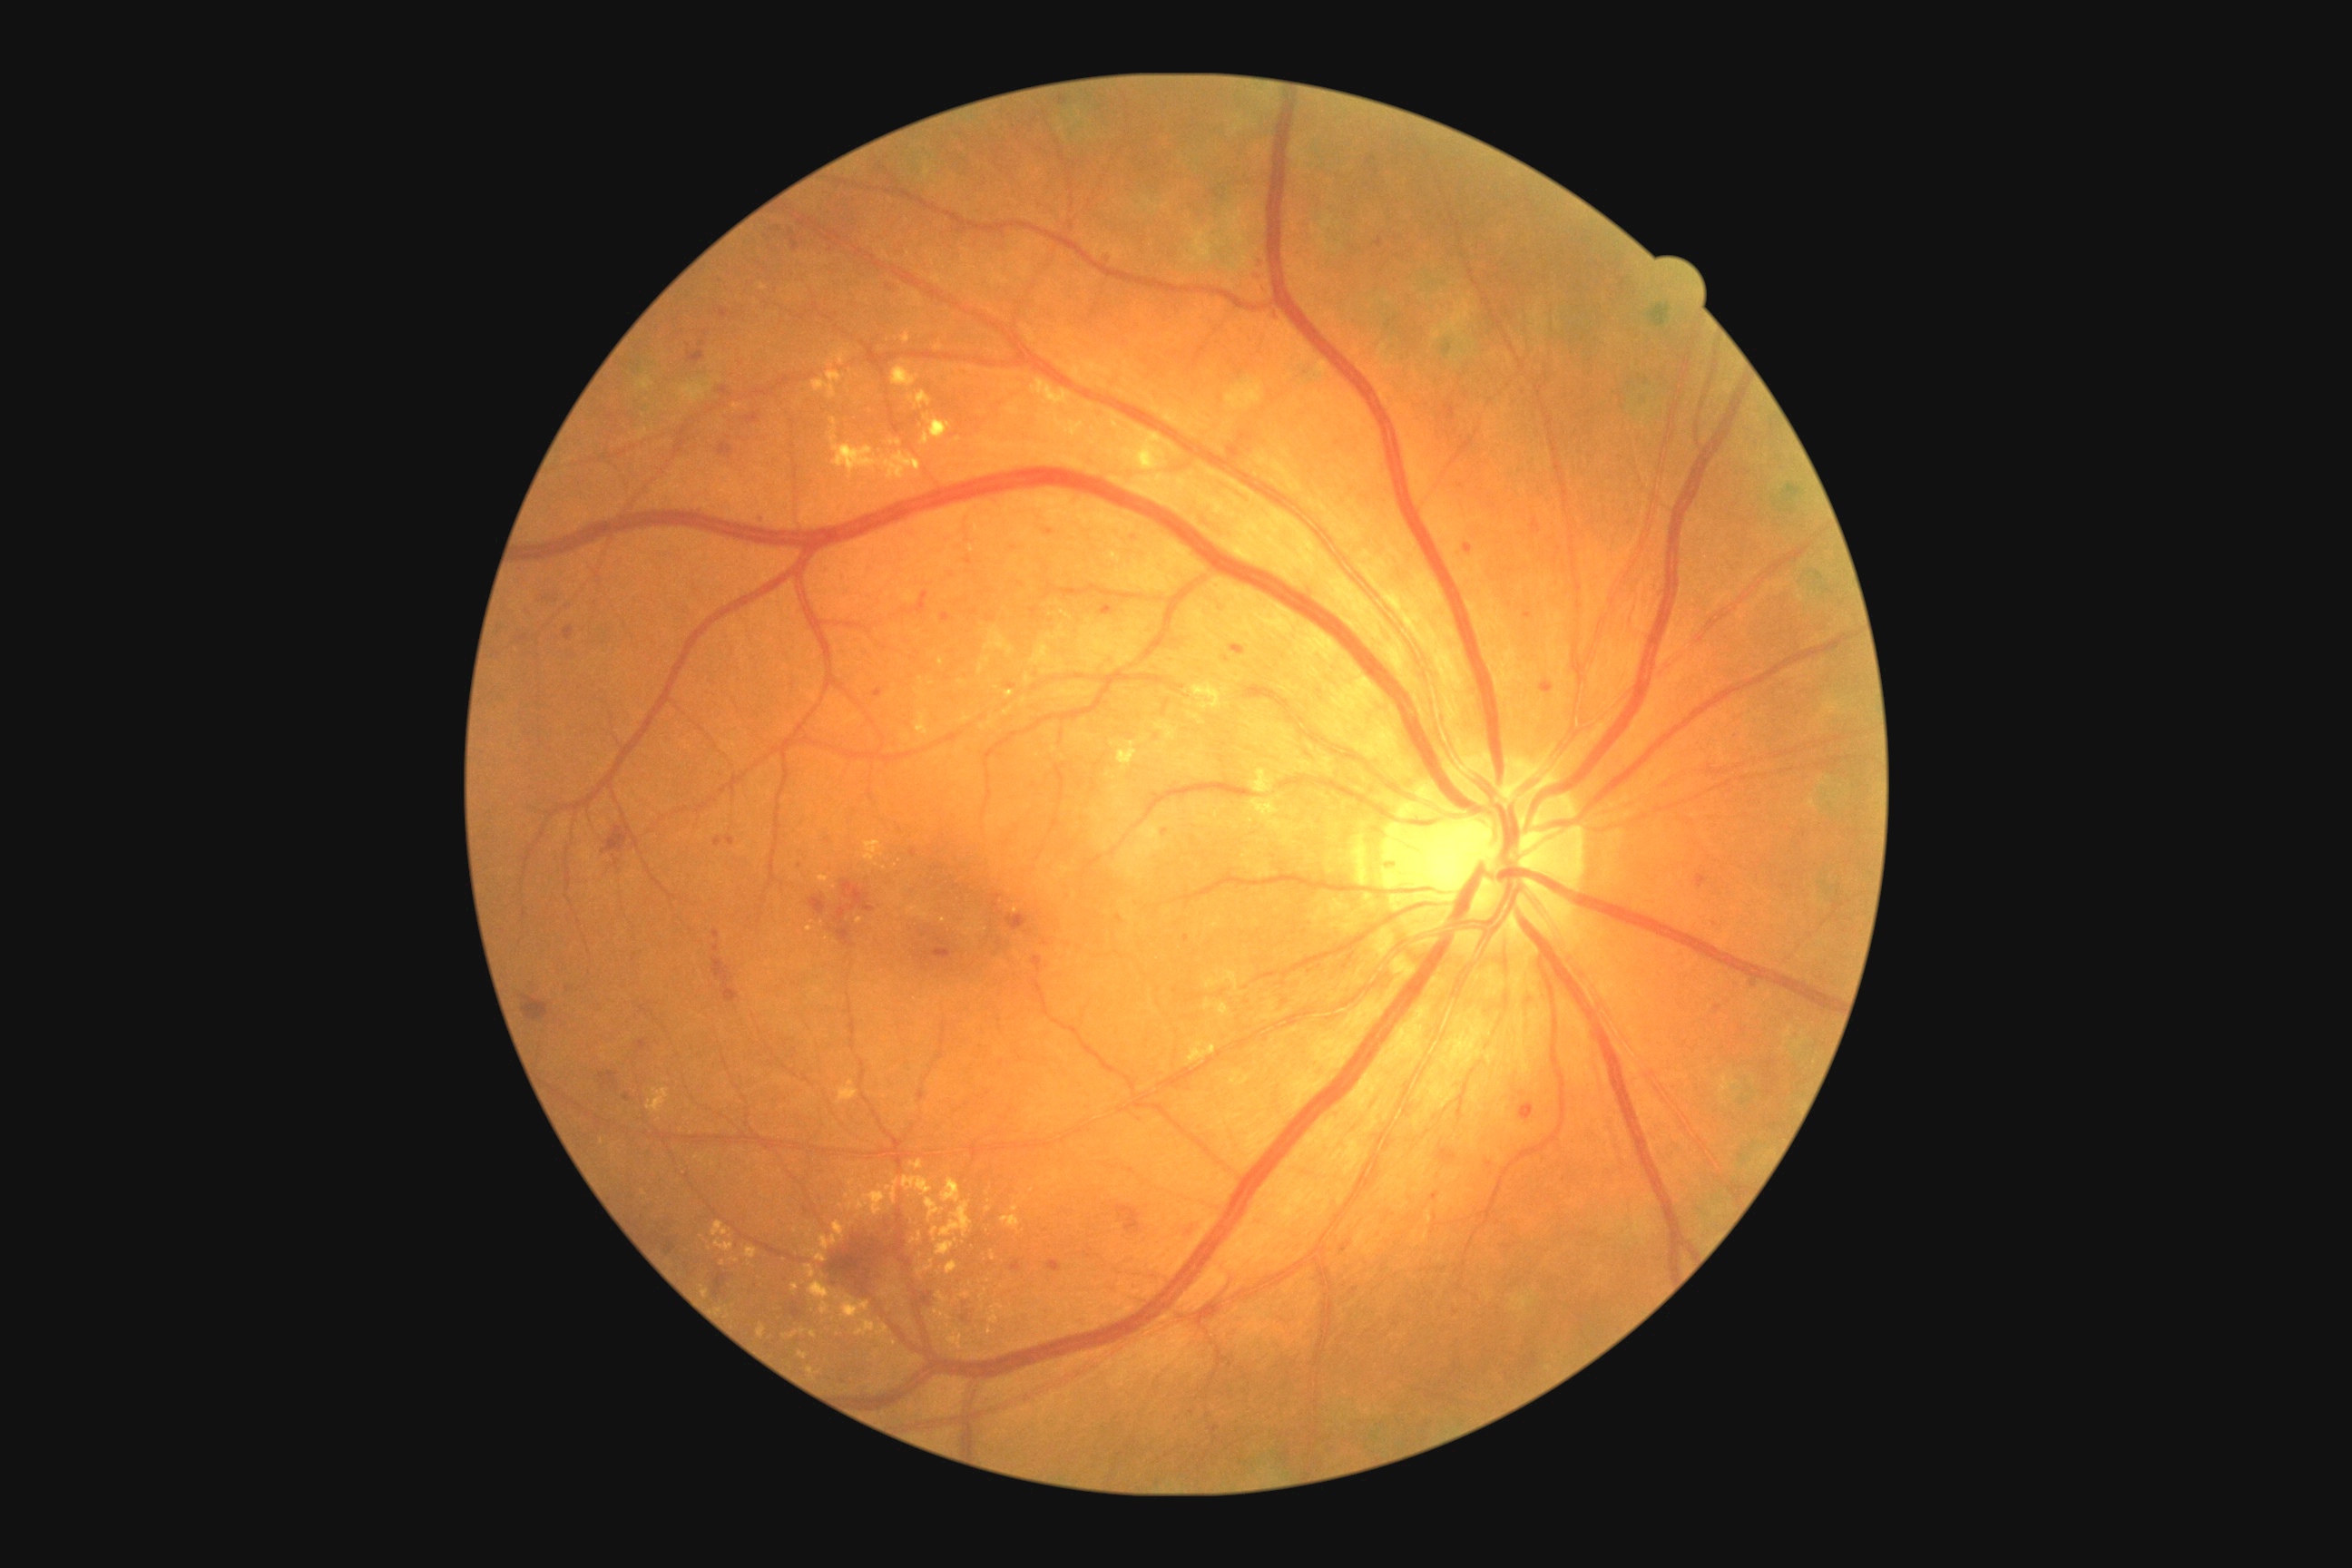
Retinopathy grade: 2 (moderate NPDR)
Representative lesions:
hard exudates (more not shown): rect(808, 1250, 827, 1262) | rect(930, 1226, 939, 1237) | rect(808, 1282, 832, 1315) | rect(745, 1248, 758, 1259) | rect(865, 841, 883, 861) | rect(647, 1088, 671, 1113) | rect(921, 415, 952, 446) | rect(848, 1181, 856, 1188) | rect(1251, 770, 1271, 794) | rect(946, 1262, 957, 1275) | rect(1251, 801, 1273, 814) | rect(961, 1291, 972, 1298)
Hard exudates (small, approximate centers) near 723:1264 | 943:921 | 735:1260 | 813:1334 | 982:1298 | 885:868 | 933:684